Natus RetCam Envision, 130° FOV. Wide-field fundus photograph of an infant. Image size 1440x1080.
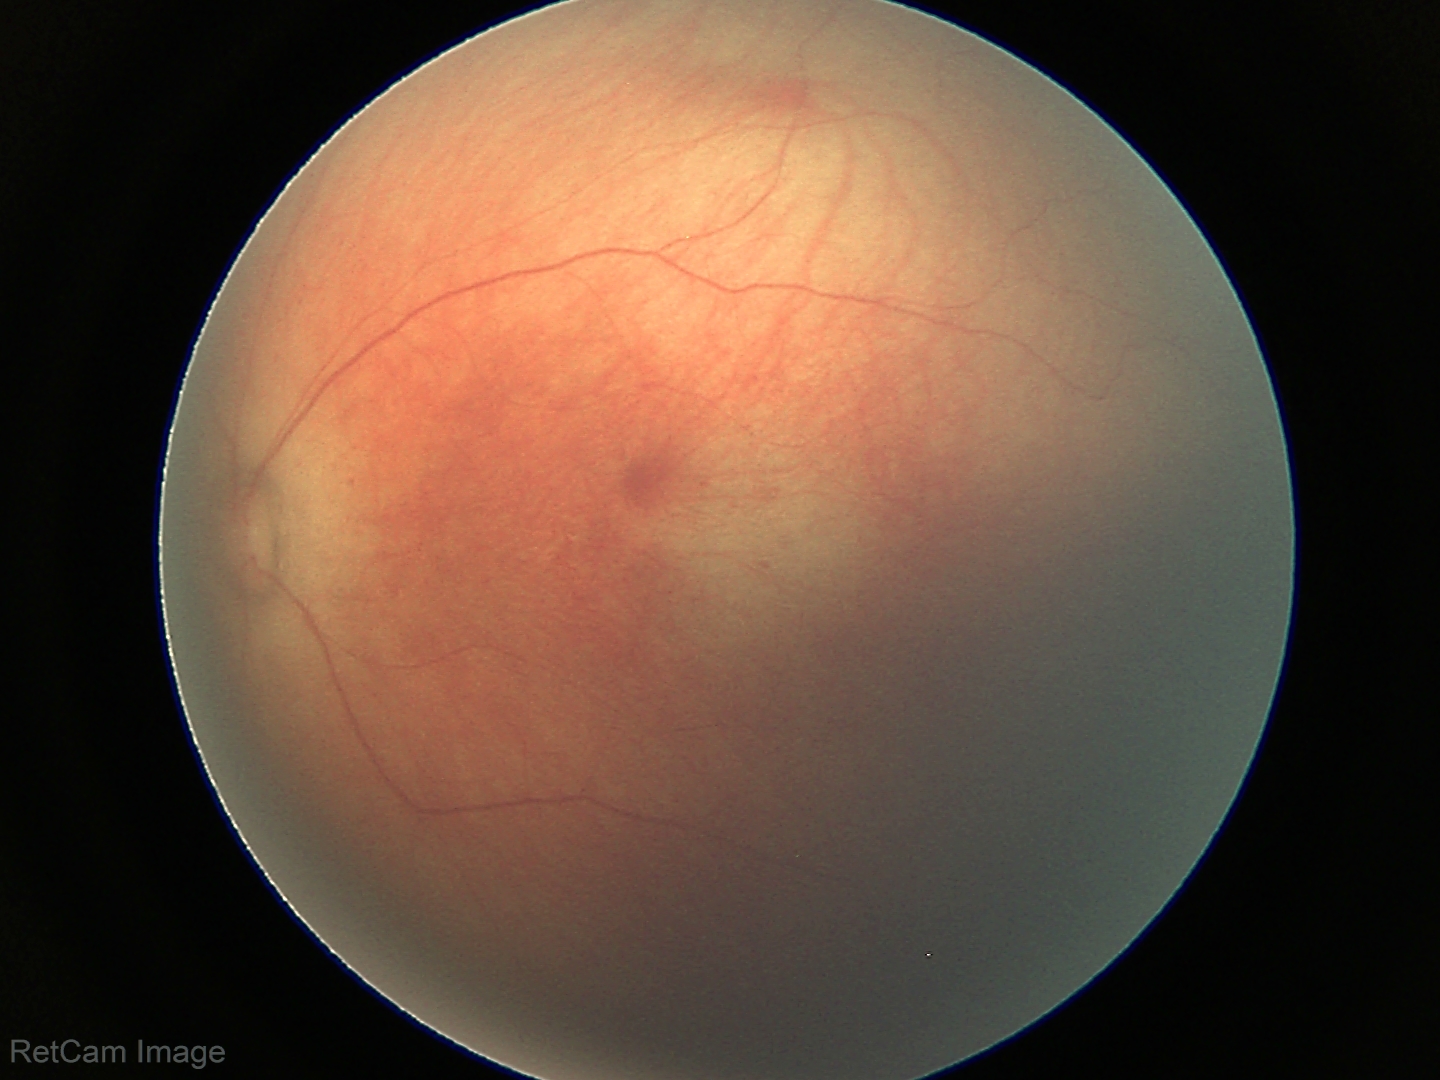

Examination with physiological retinal findings.